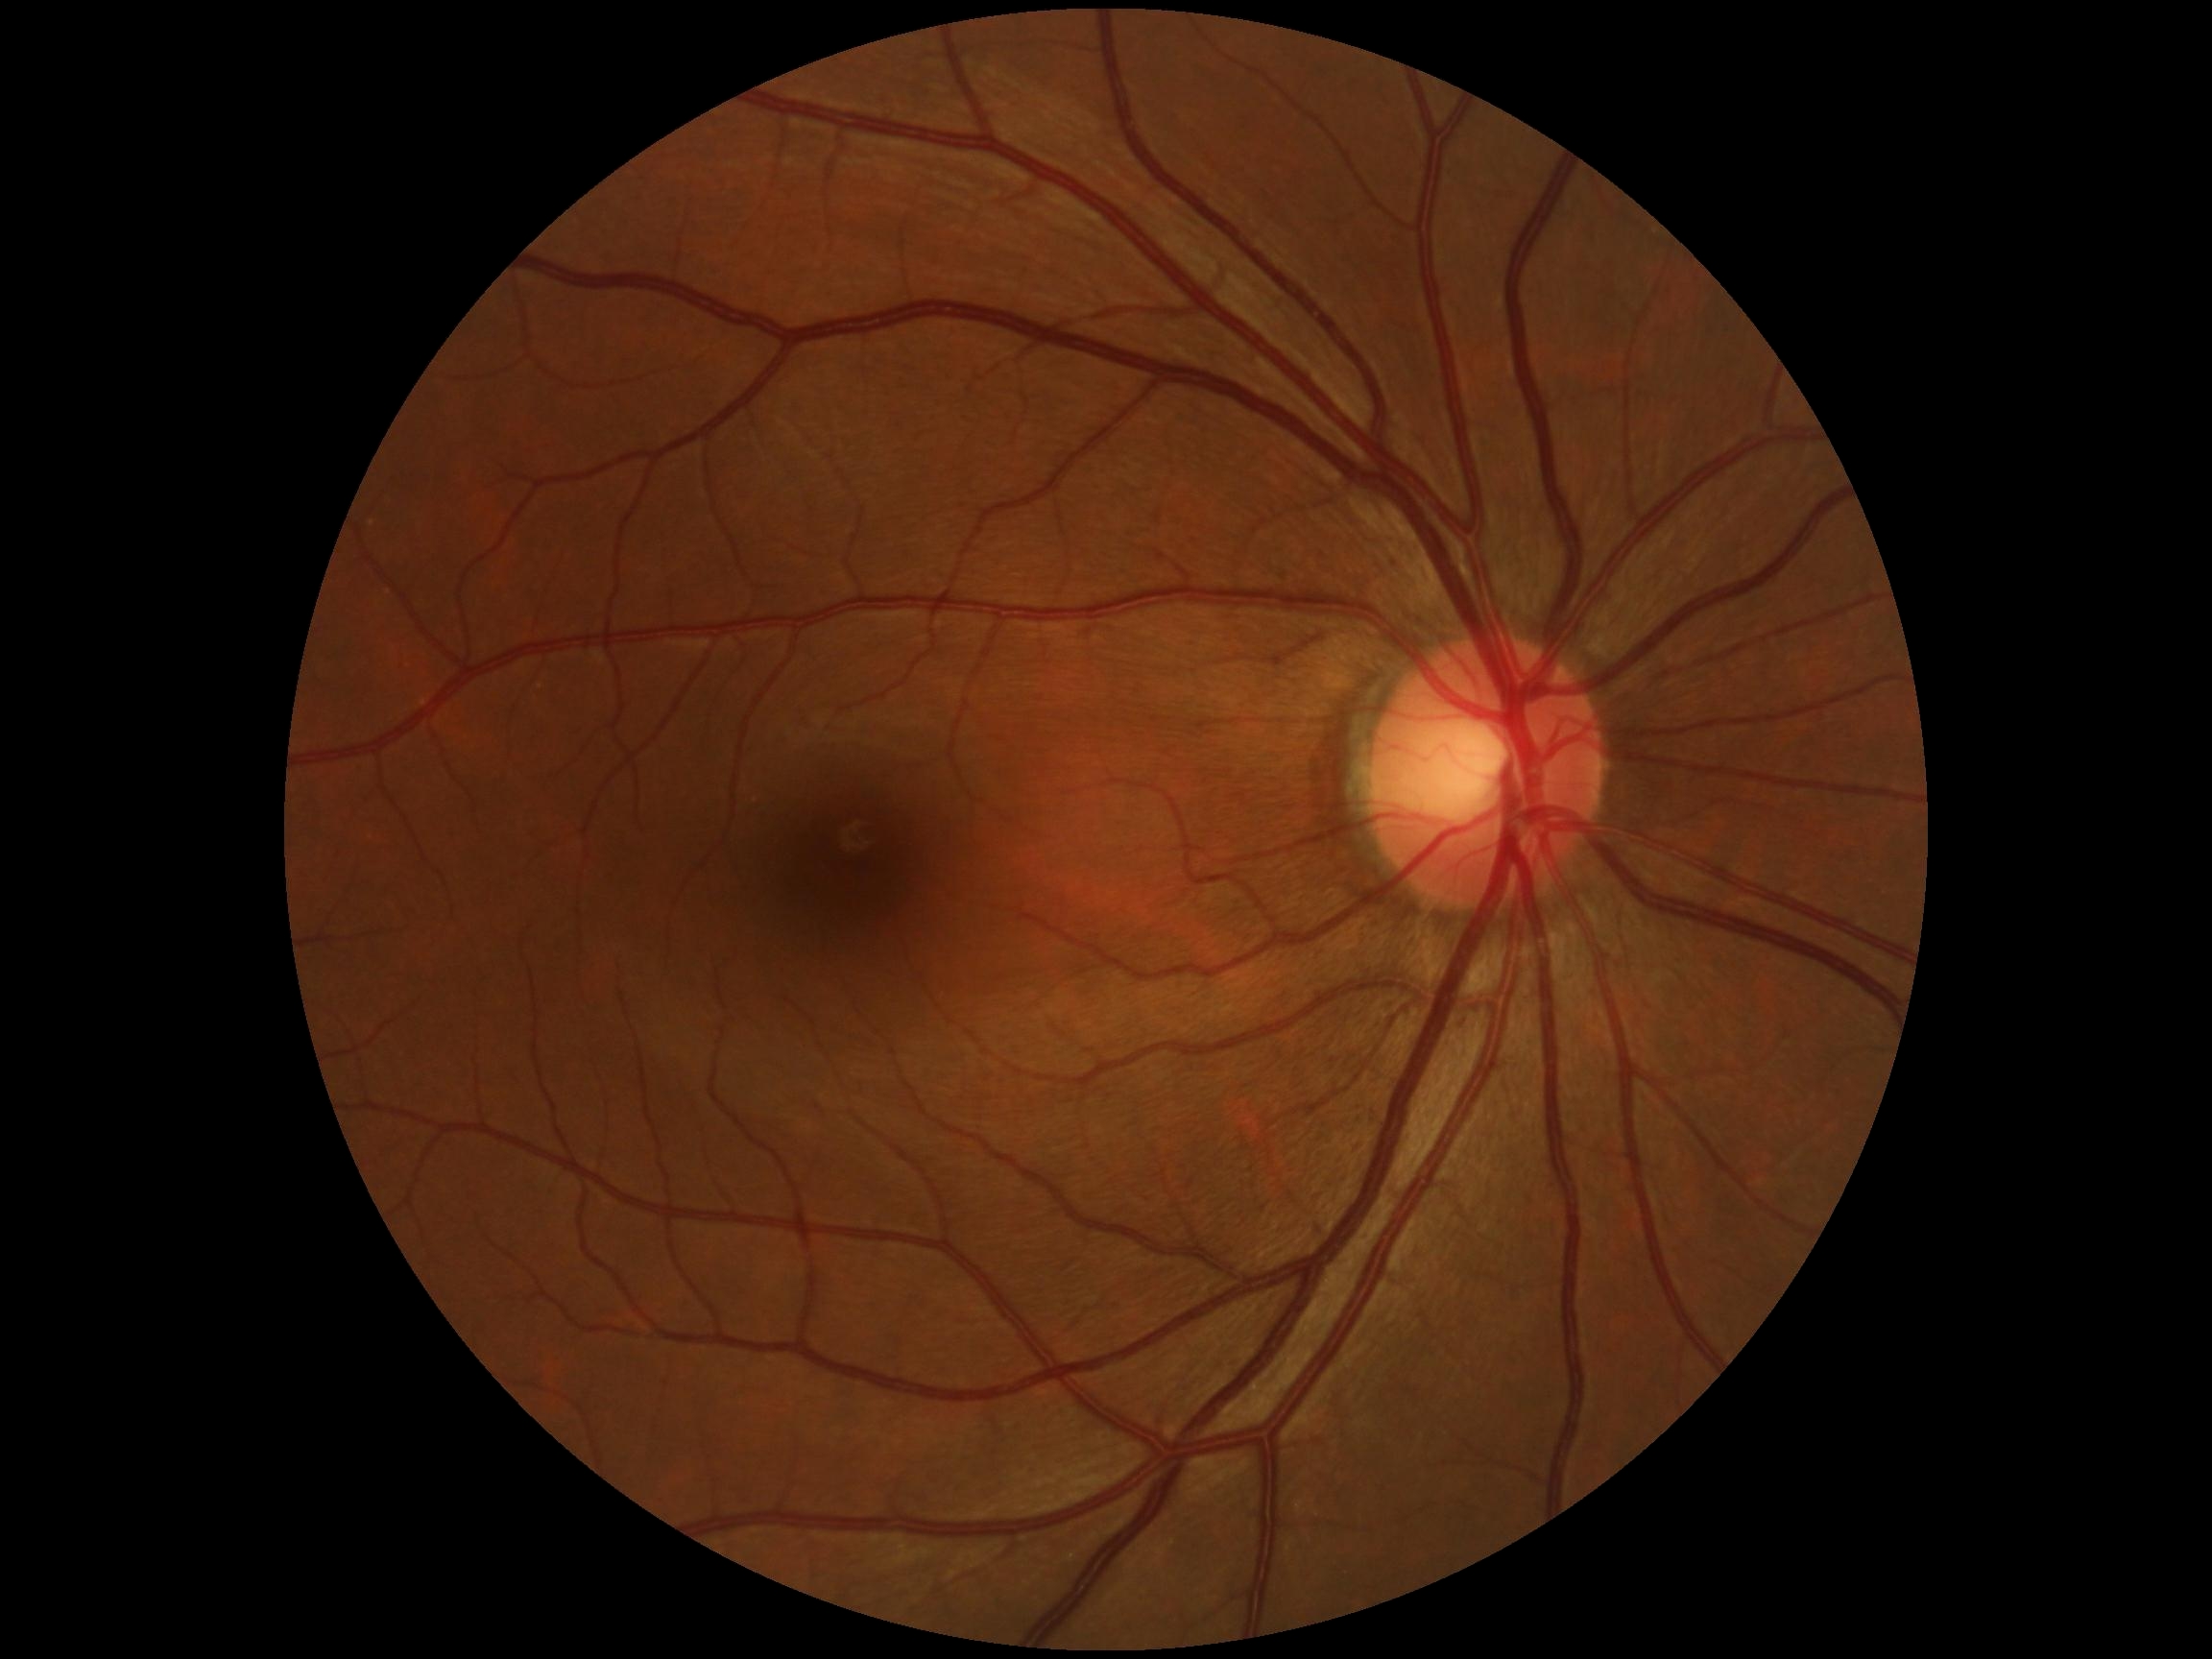

{"dr_grade": "no apparent retinopathy (grade 0)", "dr_impression": "no signs of DR"}